CFP · acquired with a NIDEK AFC-230:
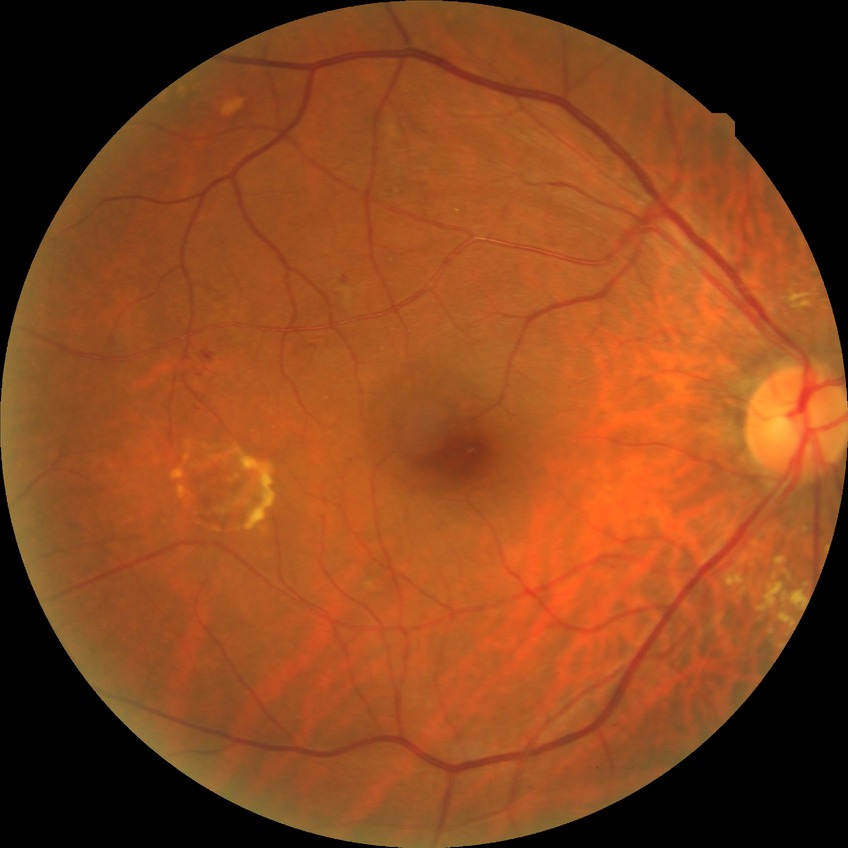
Diabetic retinopathy (DR) is SDR (simple diabetic retinopathy).